1440x1080px; infant wide-field retinal image
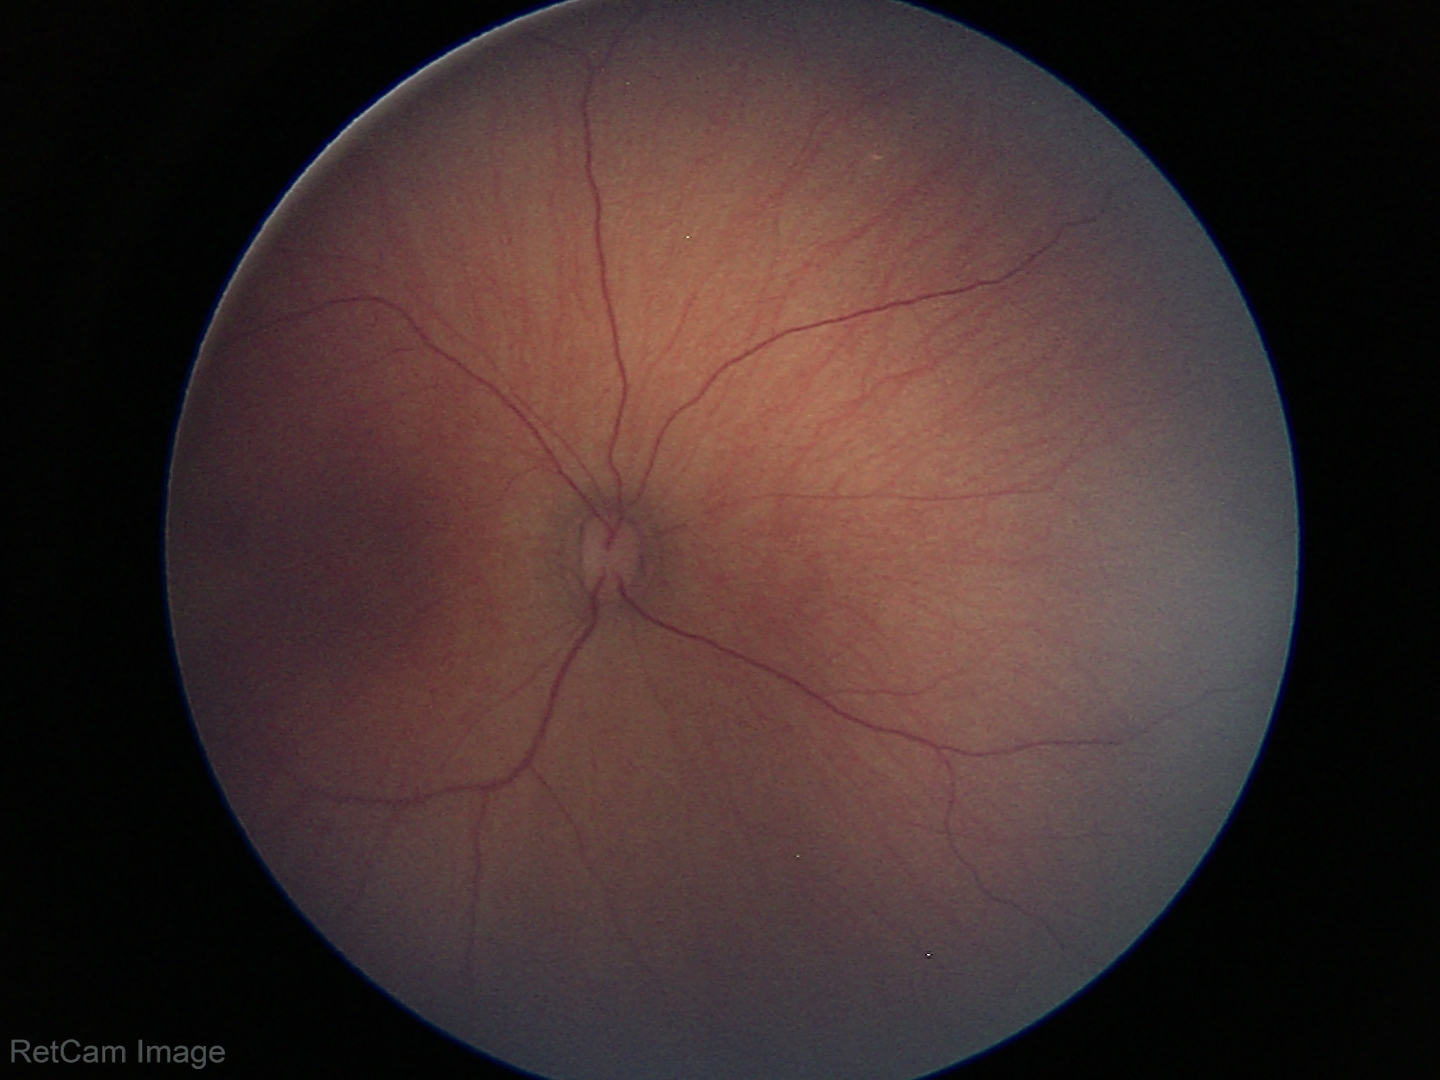

No retinal pathology identified on screening.